2228x1652, camera: Topcon TRC-50DX, mydriatic (tropicamide and phenylephrine), 50° field of view, CFP
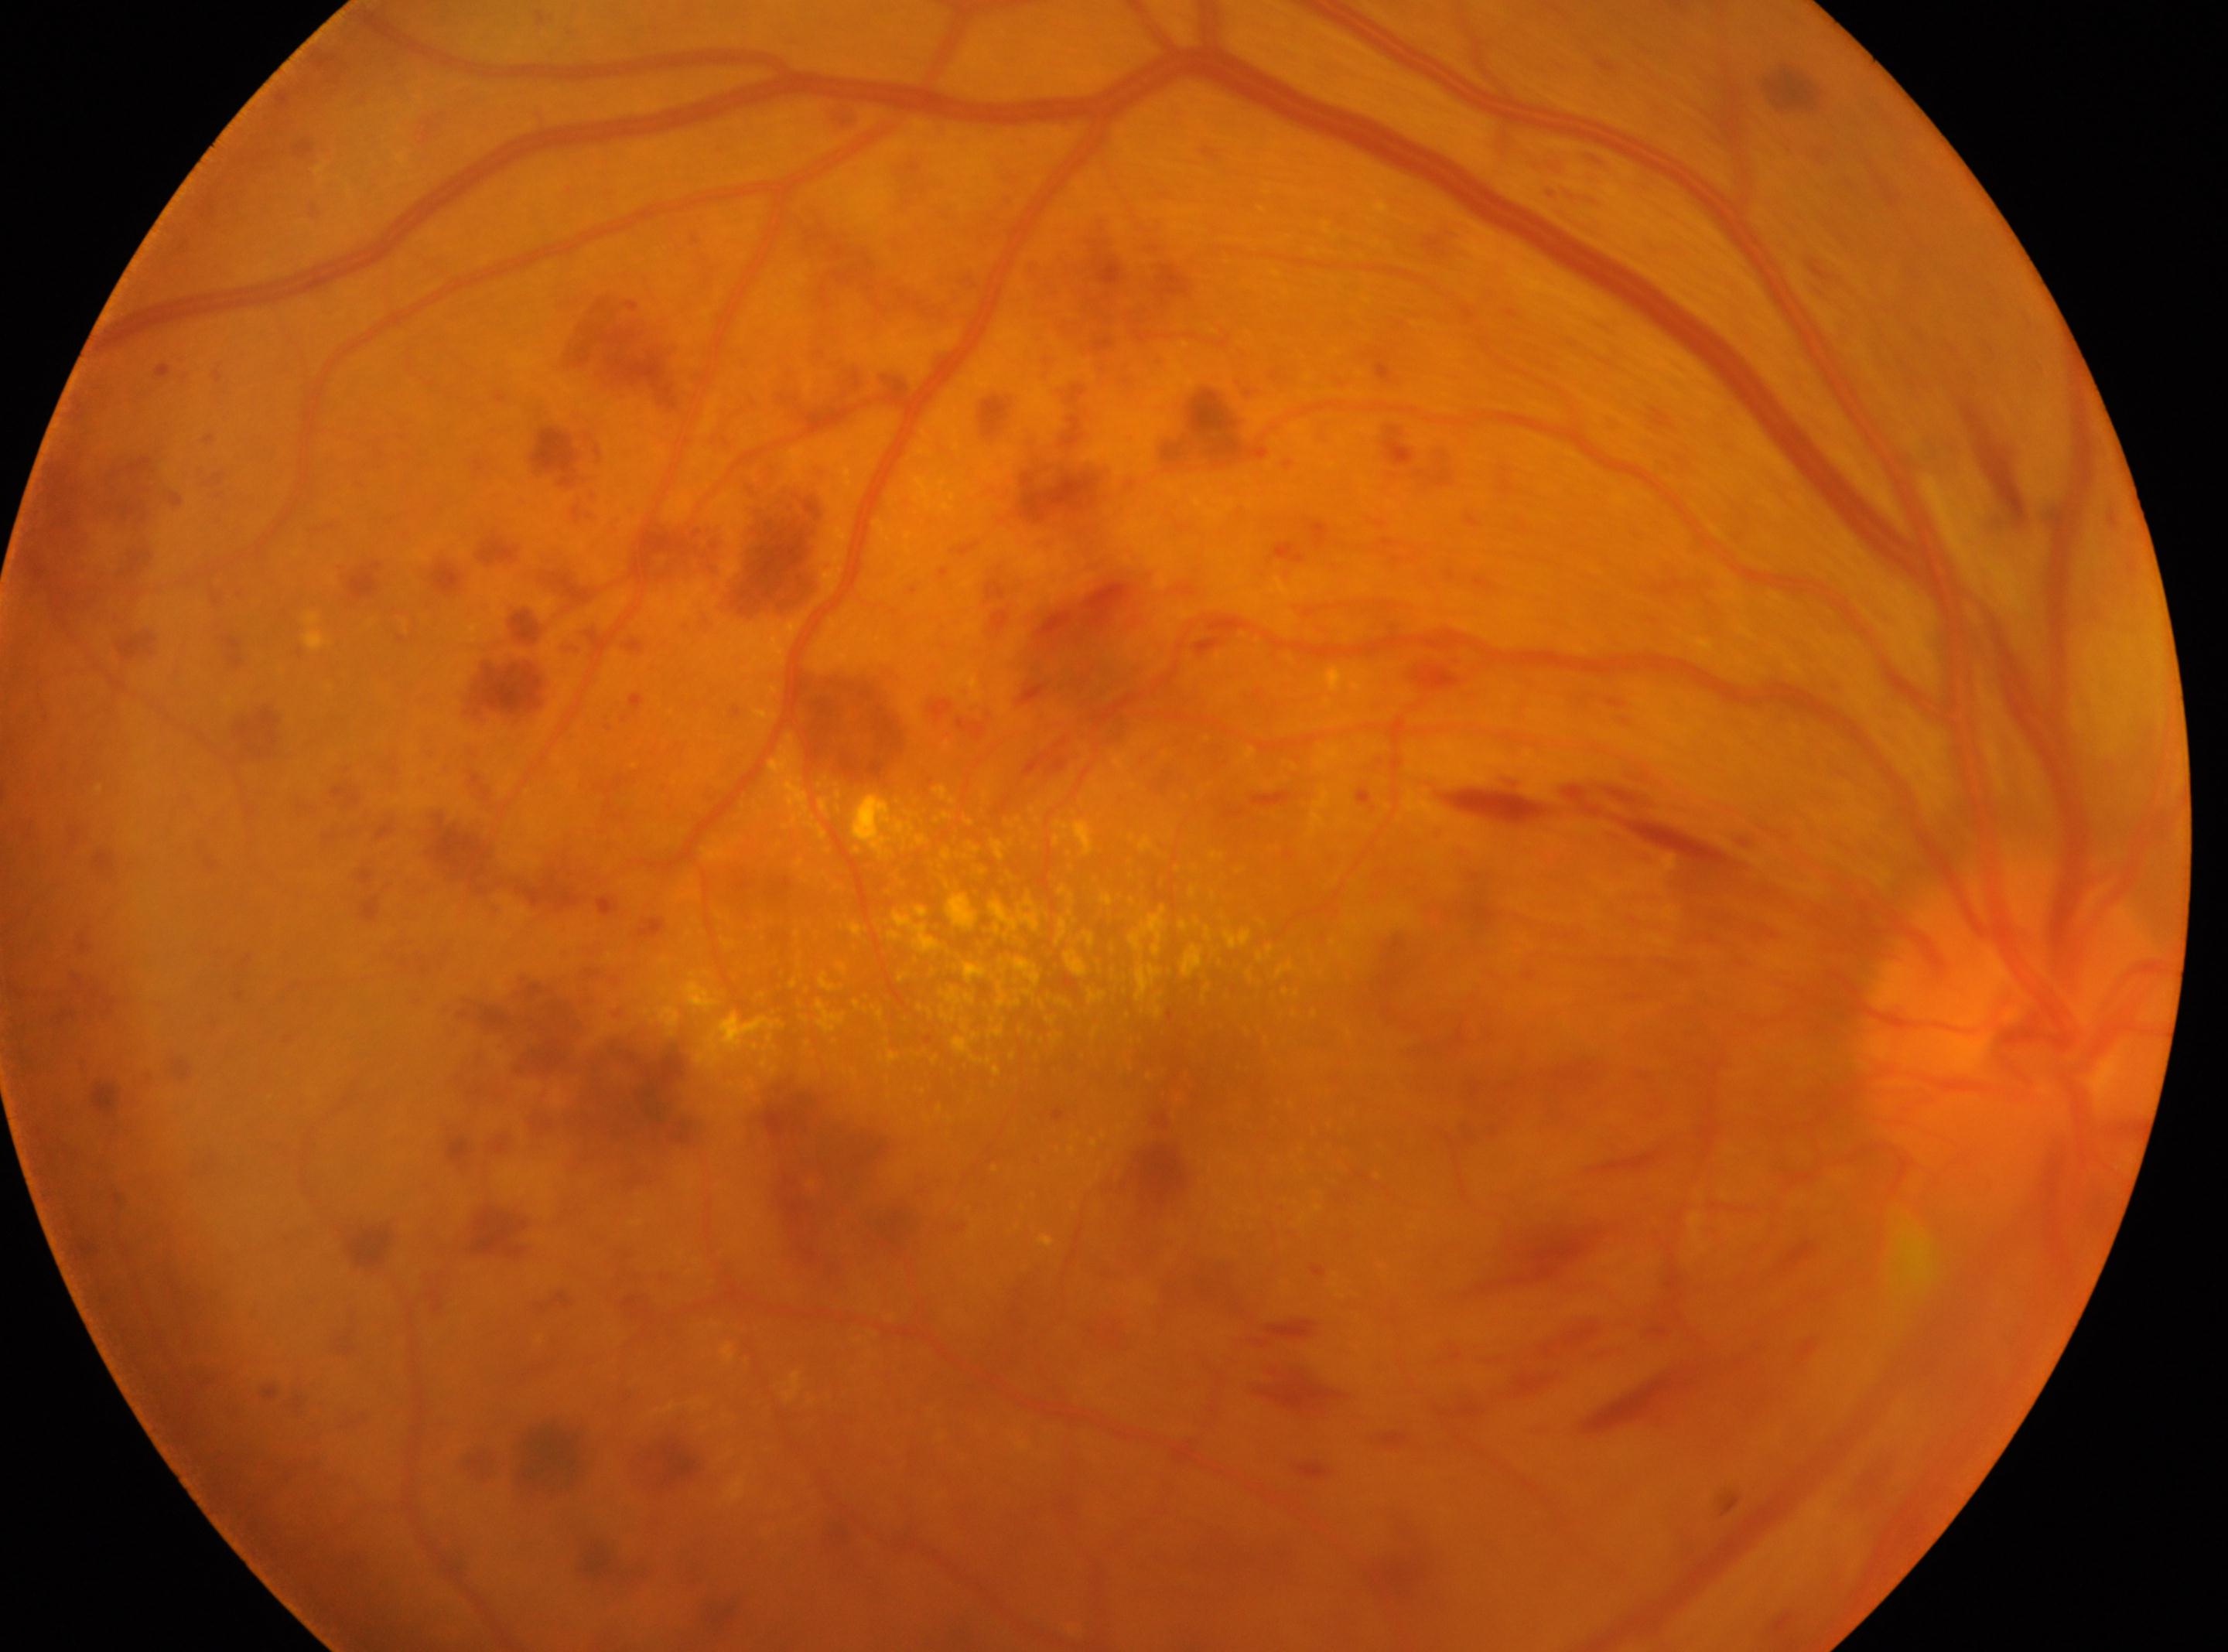
Disease class: proliferative diabetic retinopathy. ONH: [2016, 1027]. This is the right eye. DR: grade 4 (PDR). Foveal center: [1196, 1056].